45° field of view. Nonmydriatic fundus photograph:
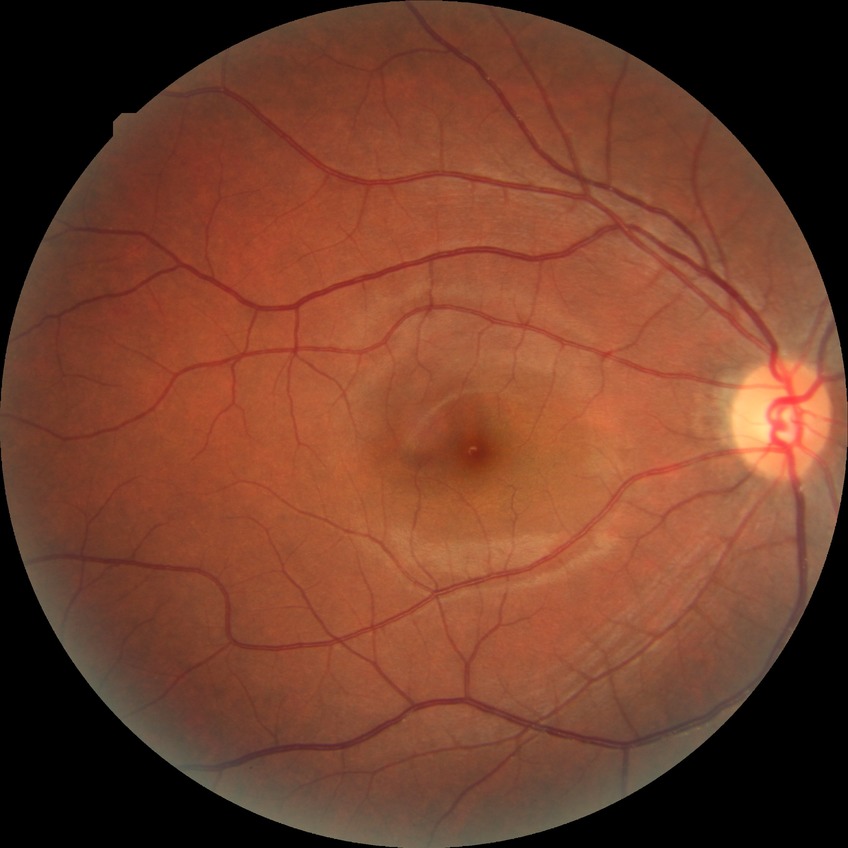
Diabetic retinopathy (DR): NDR (no diabetic retinopathy).